50° field of view
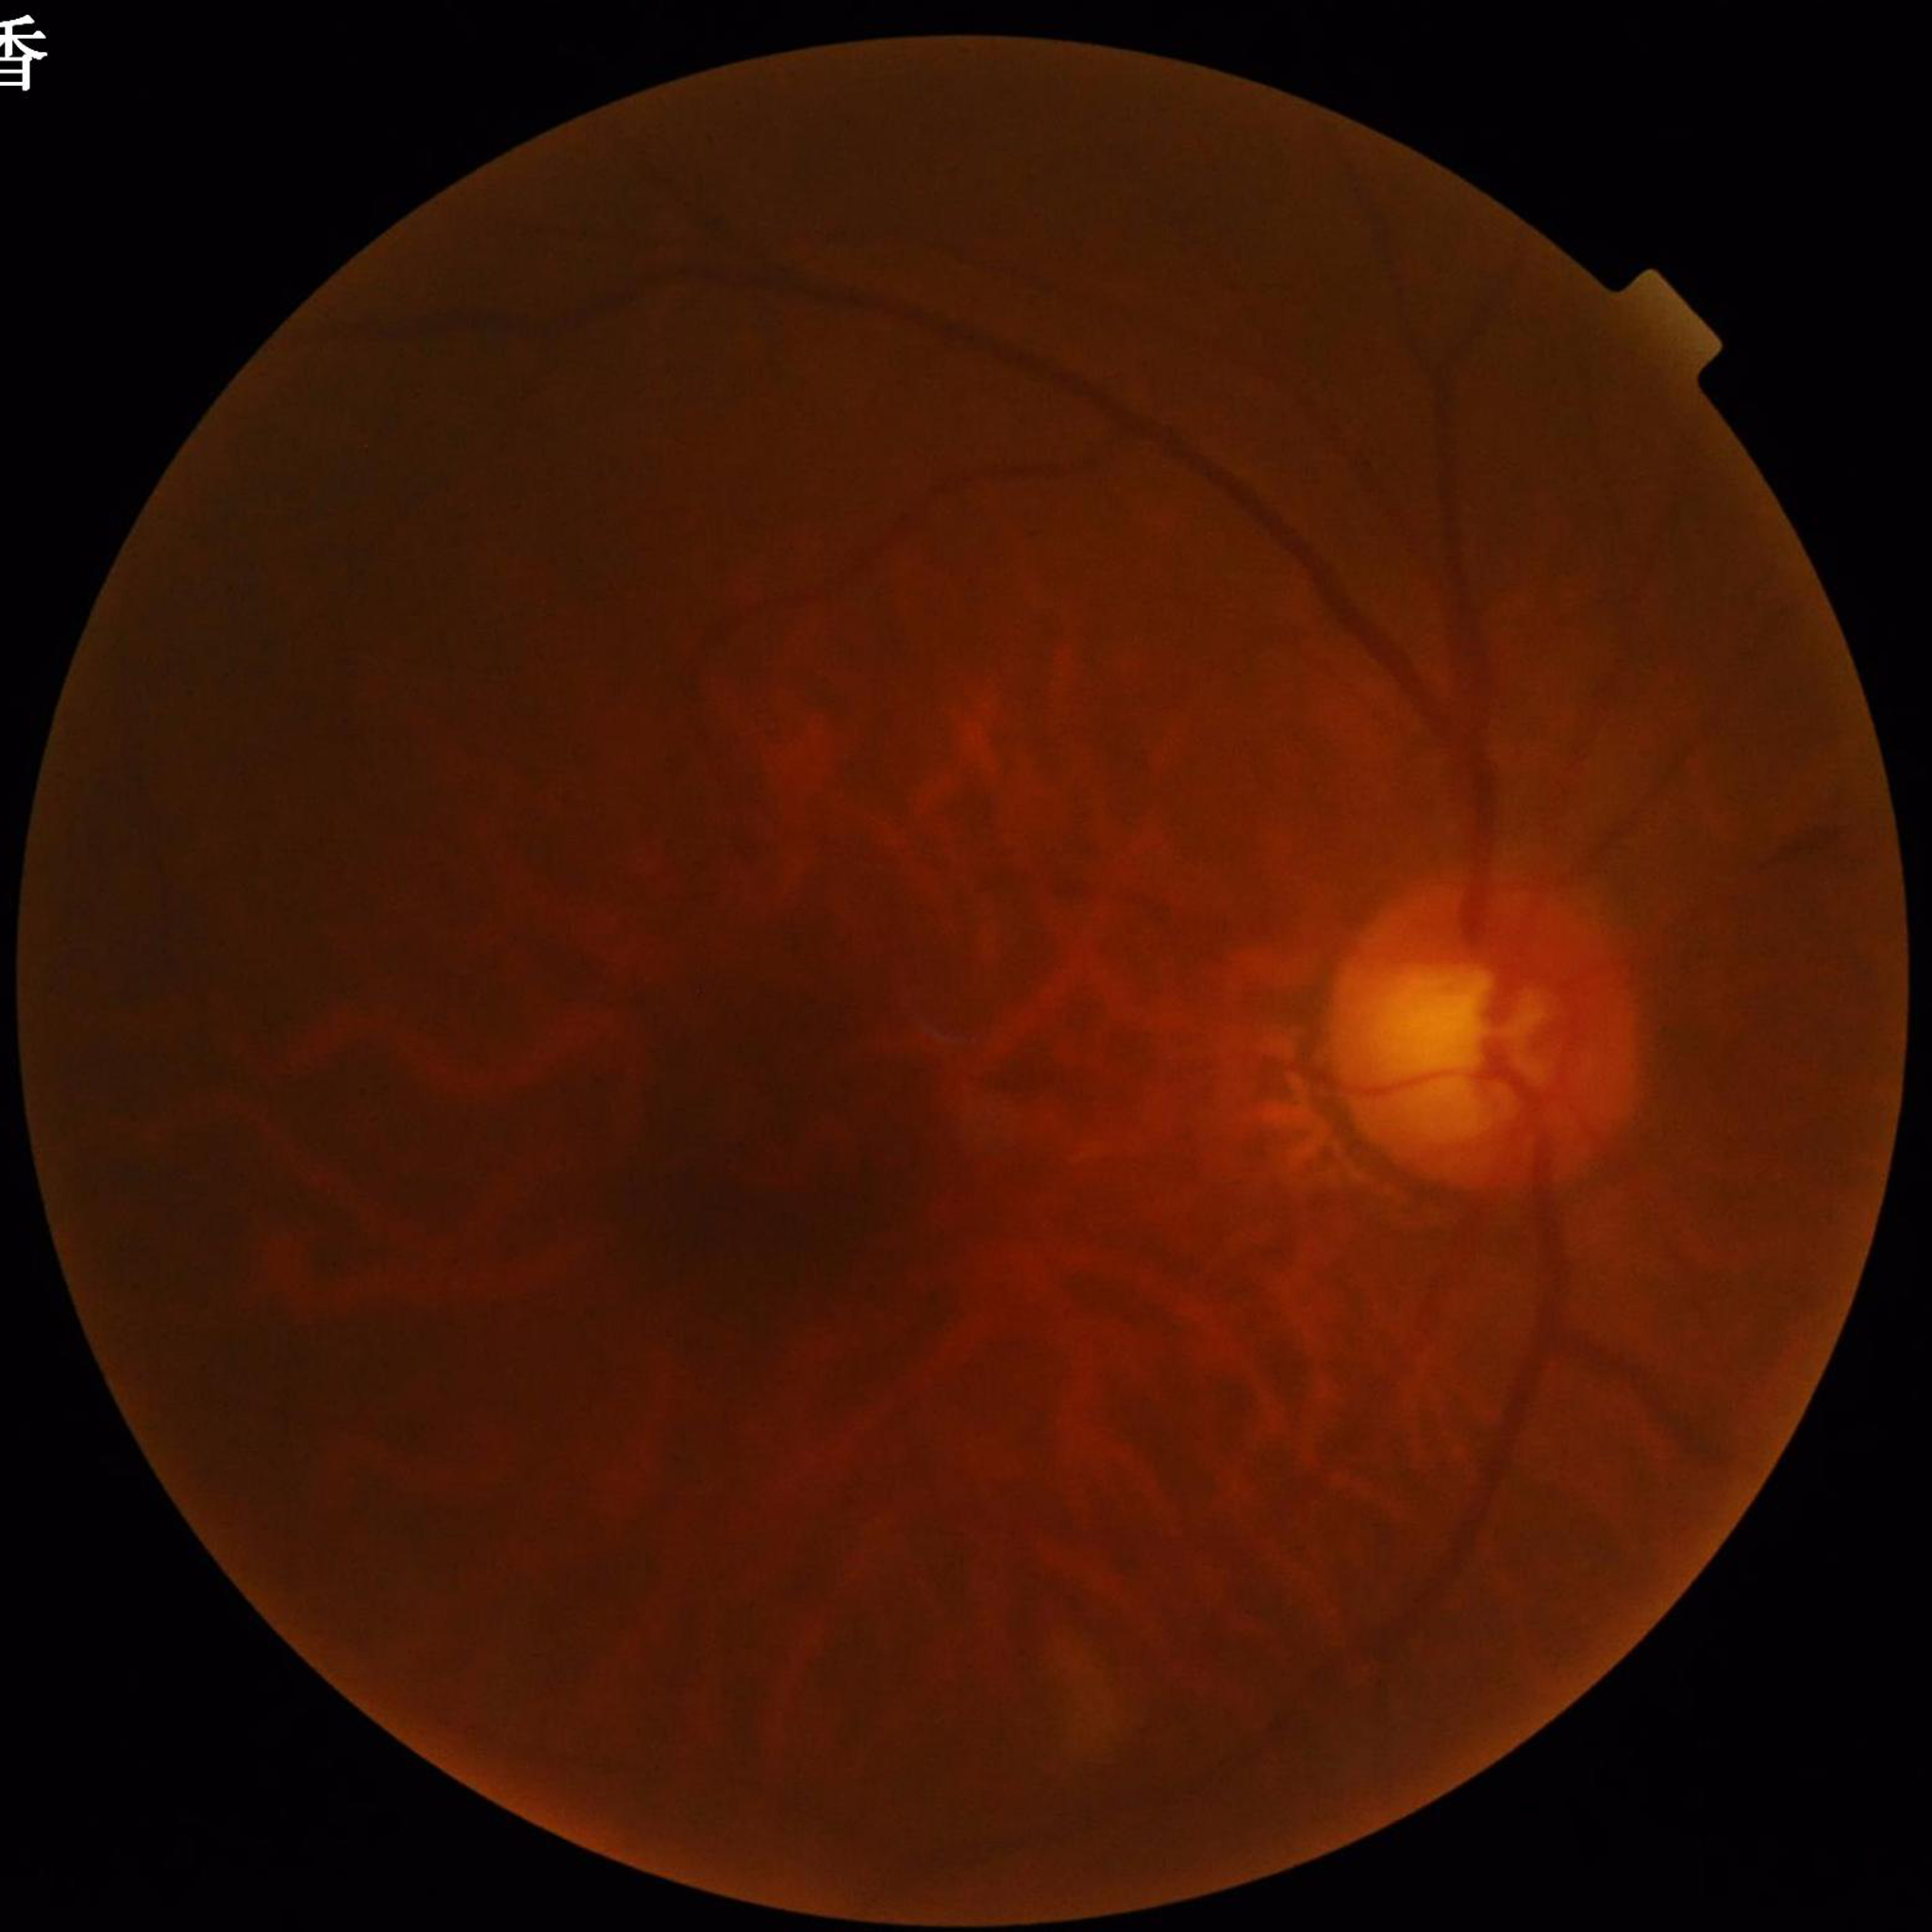 Patient diagnosed with glaucoma.